848x848px. Graded on the modified Davis scale
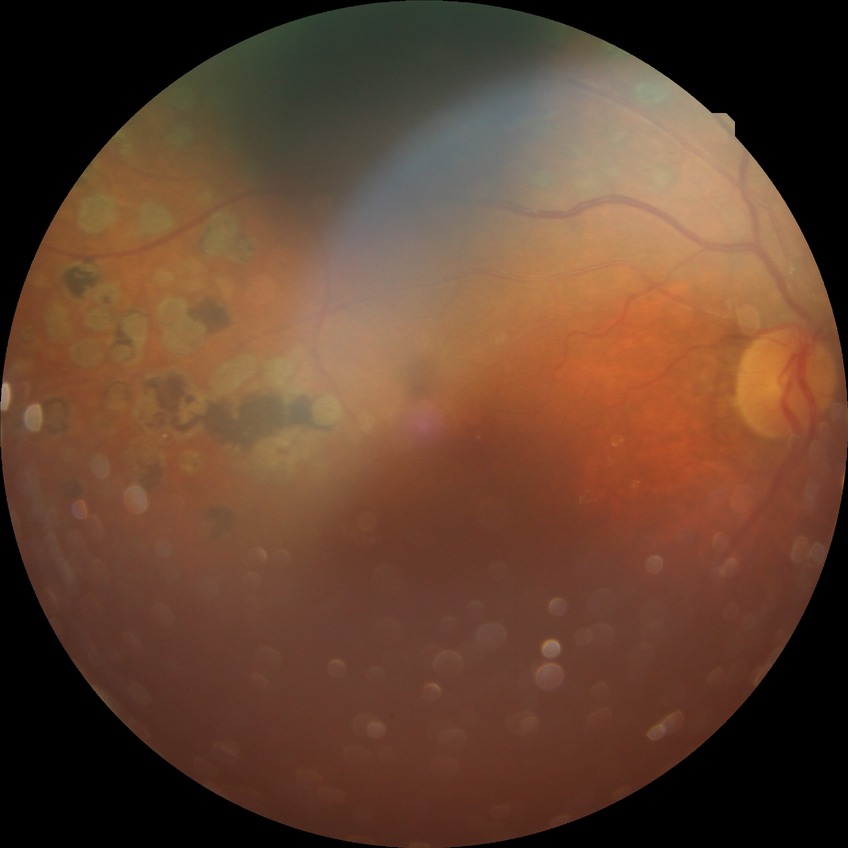
DR stage: PDR.